Camera: Phoenix ICON (100° FOV); wide-field fundus photograph of an infant:
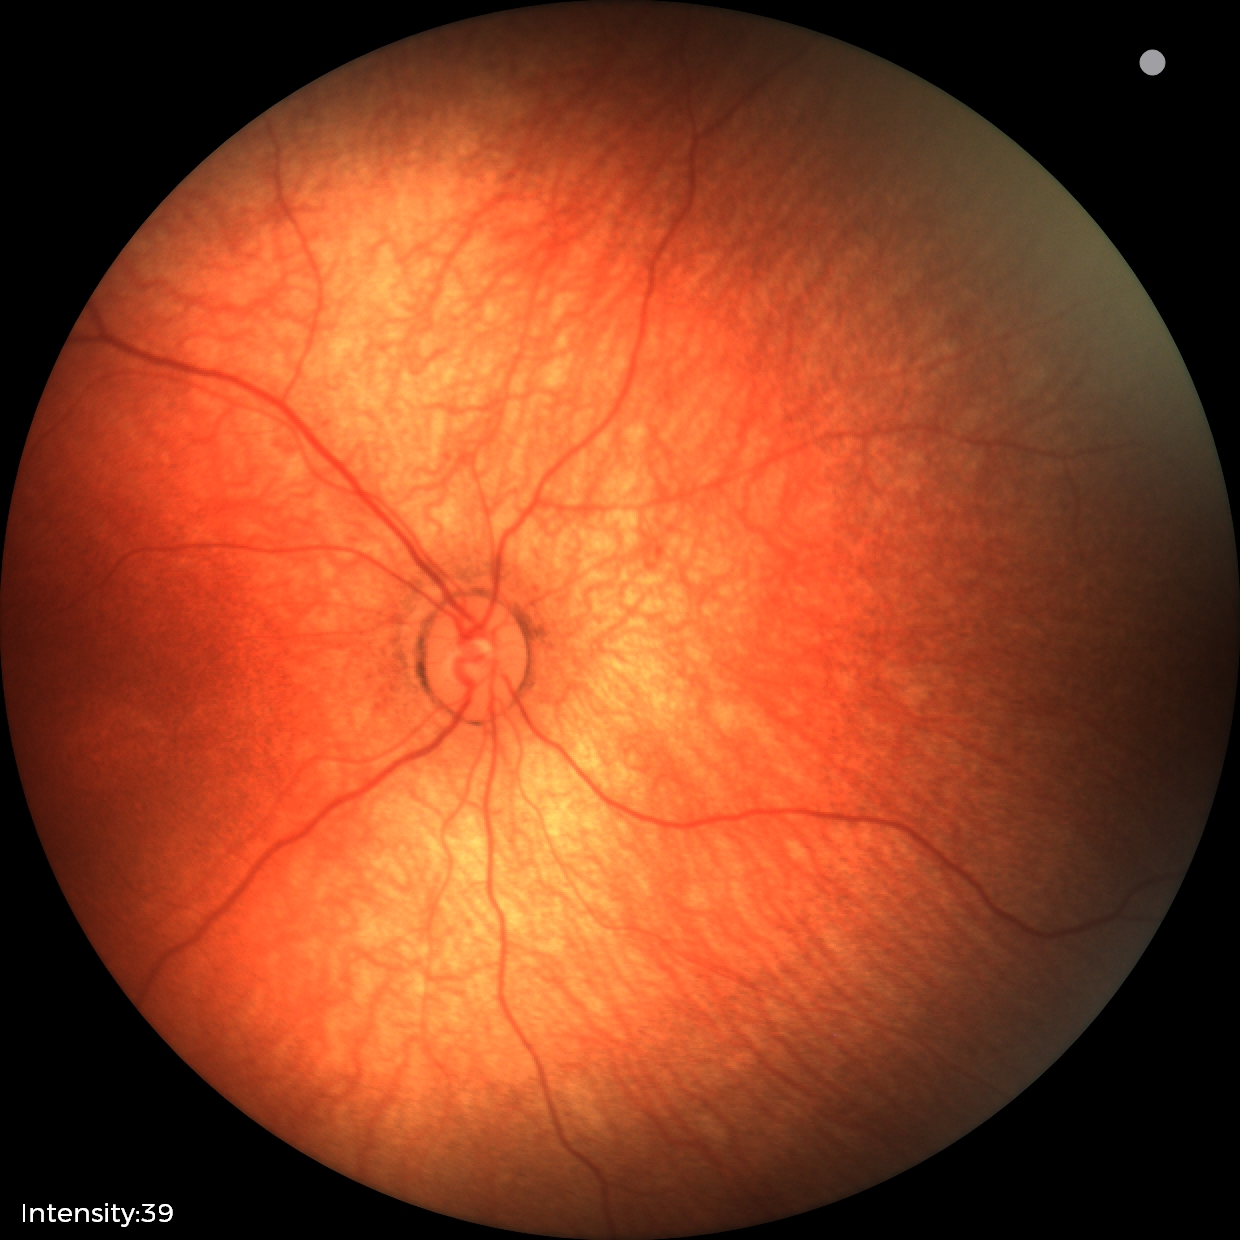

Impression: normal fundus examination.